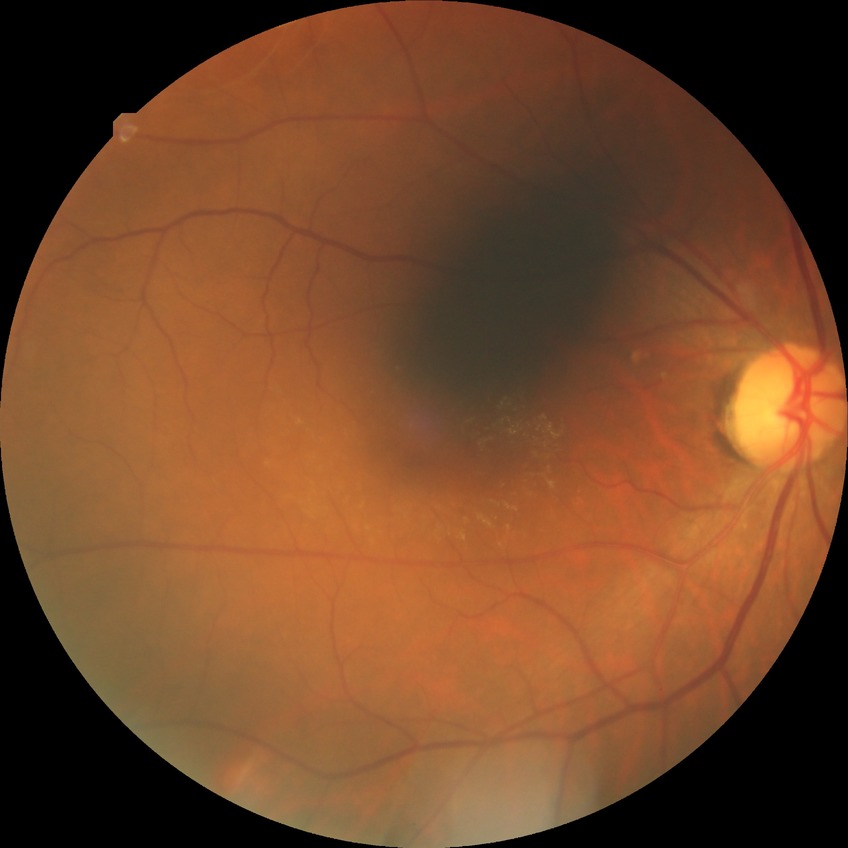

Diabetic retinopathy (DR) is NDR (no diabetic retinopathy).